640x480px · infant wide-field fundus photograph: 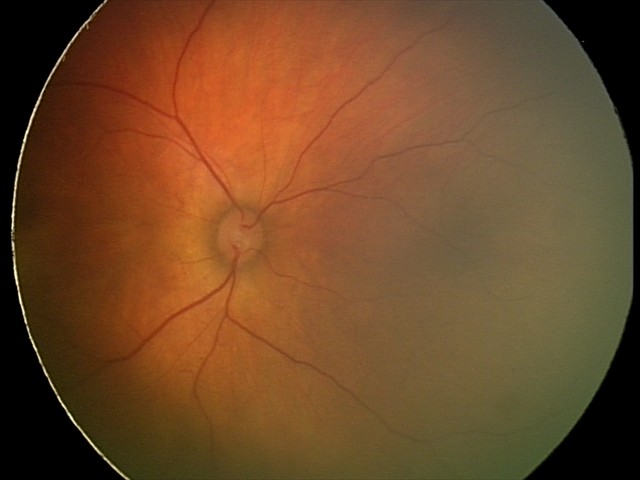
Diagnosis: retinal hemorrhages